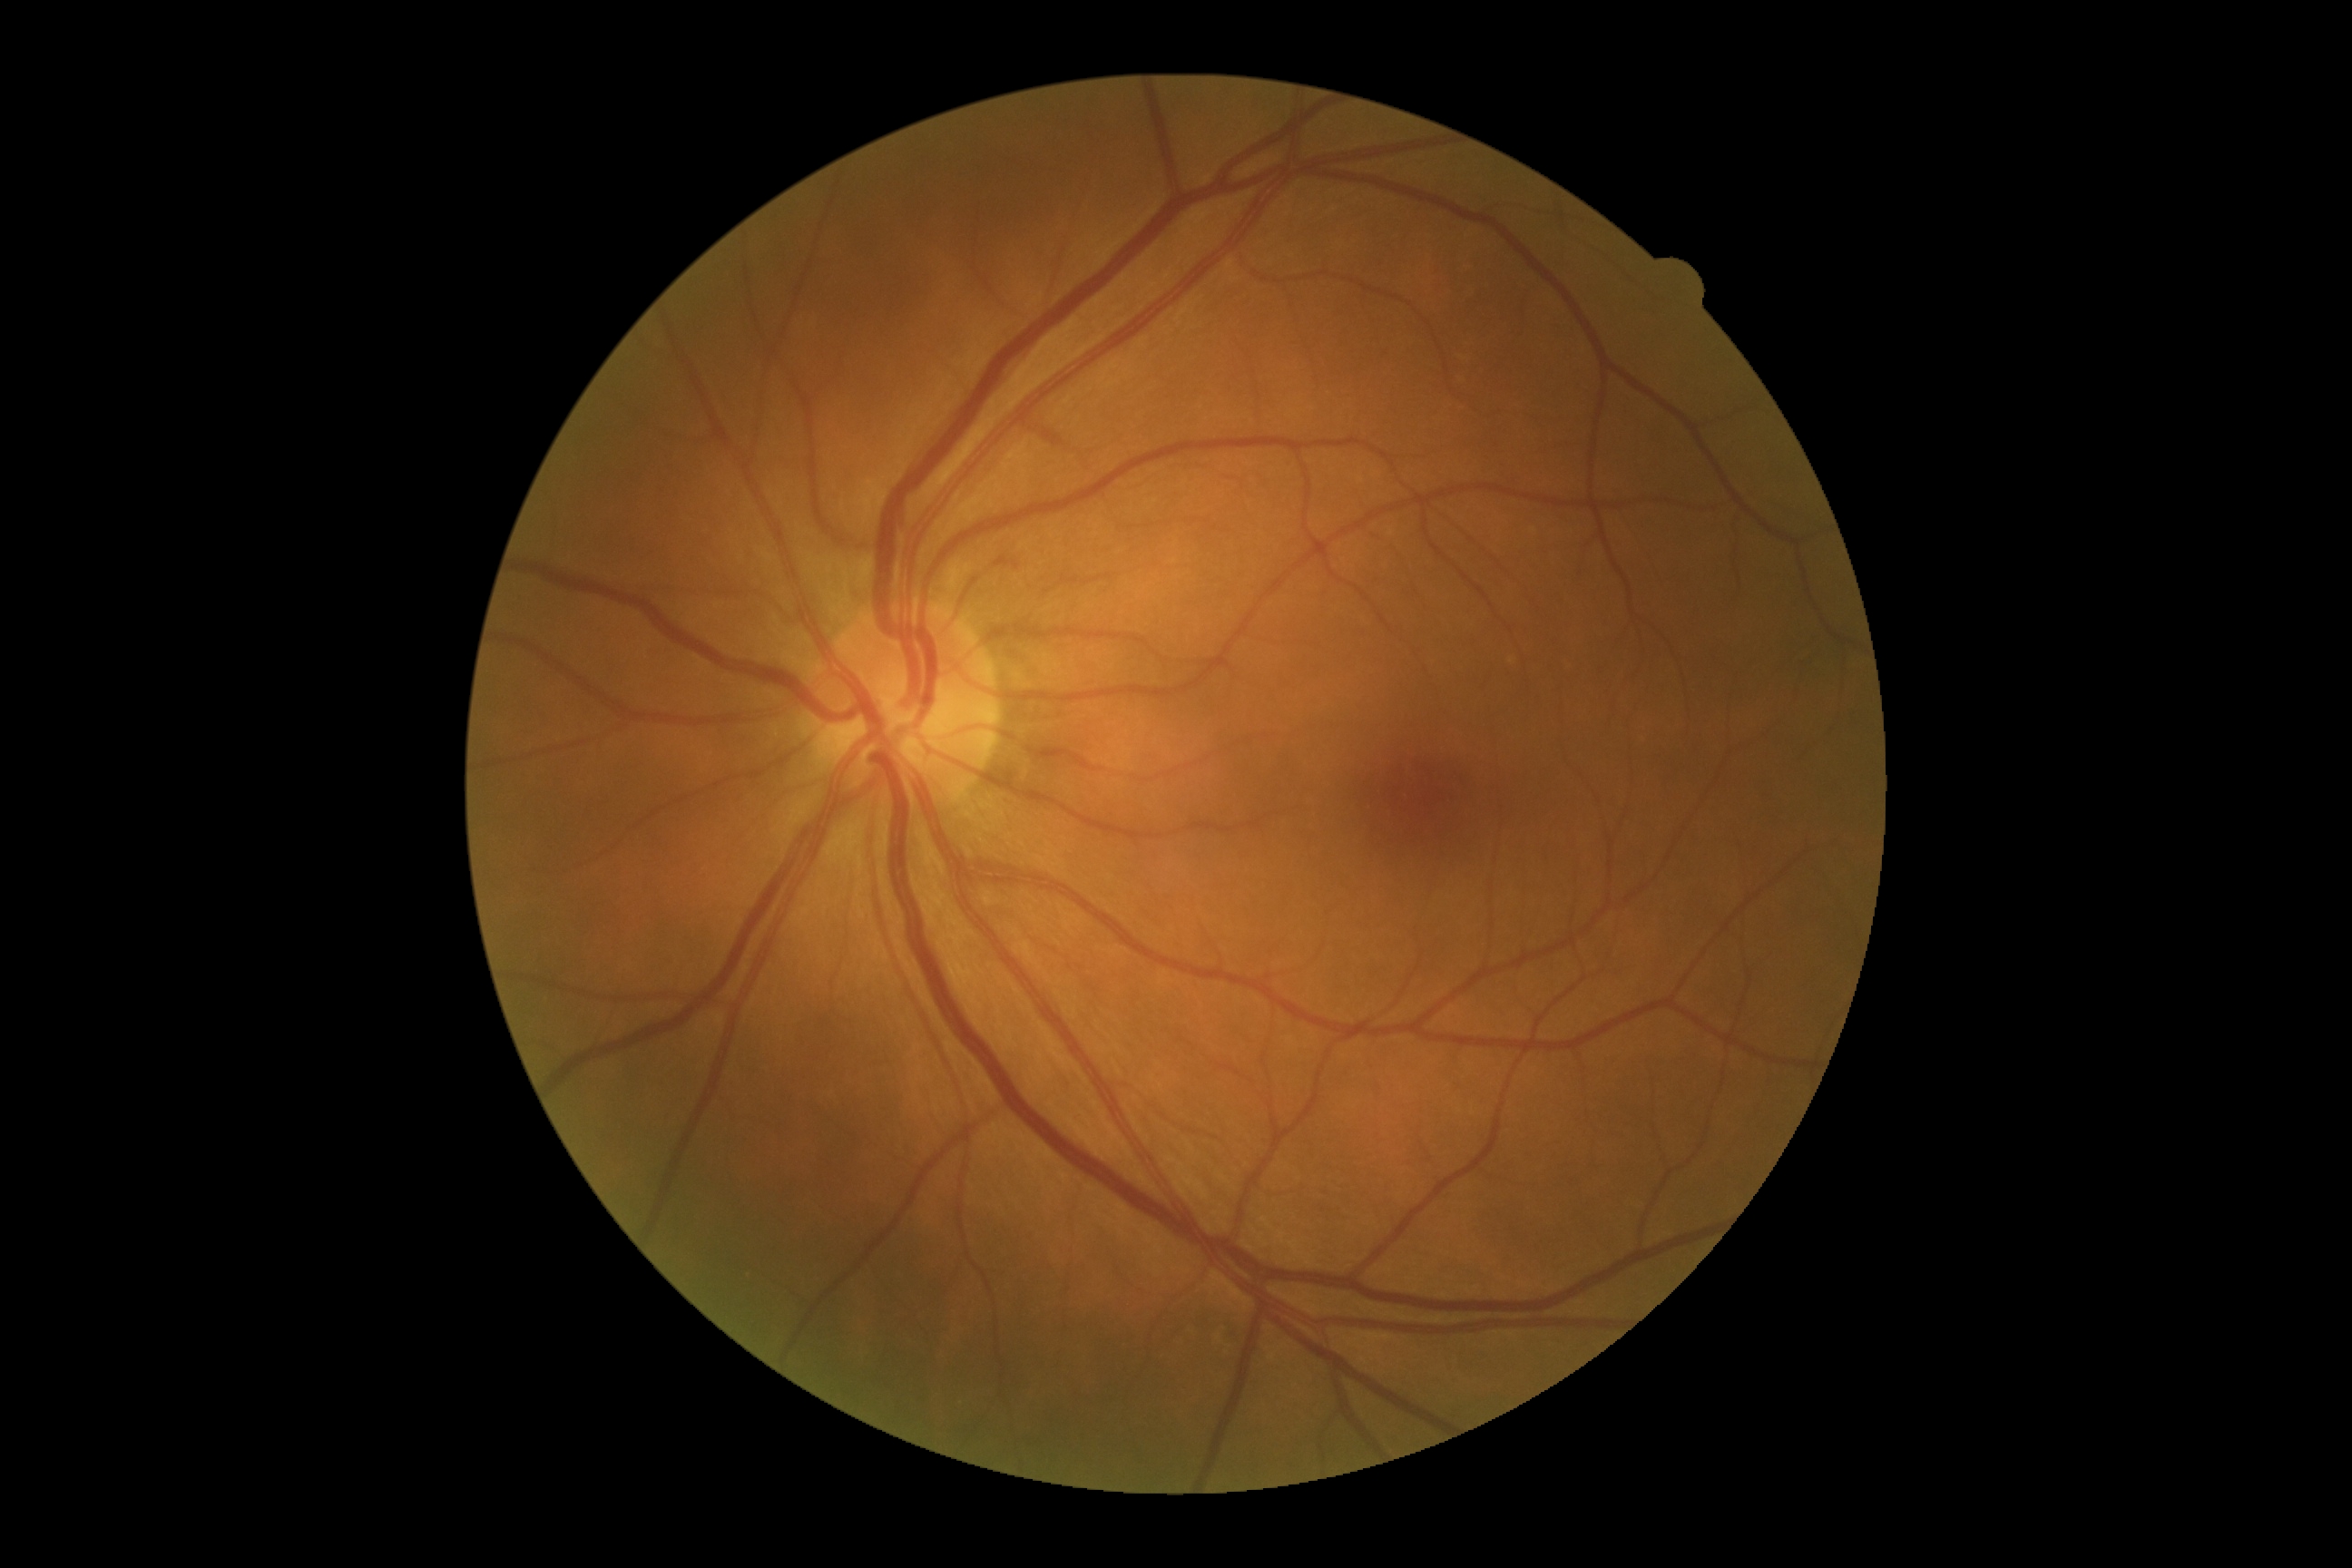 * DR grade — no apparent retinopathy (0)